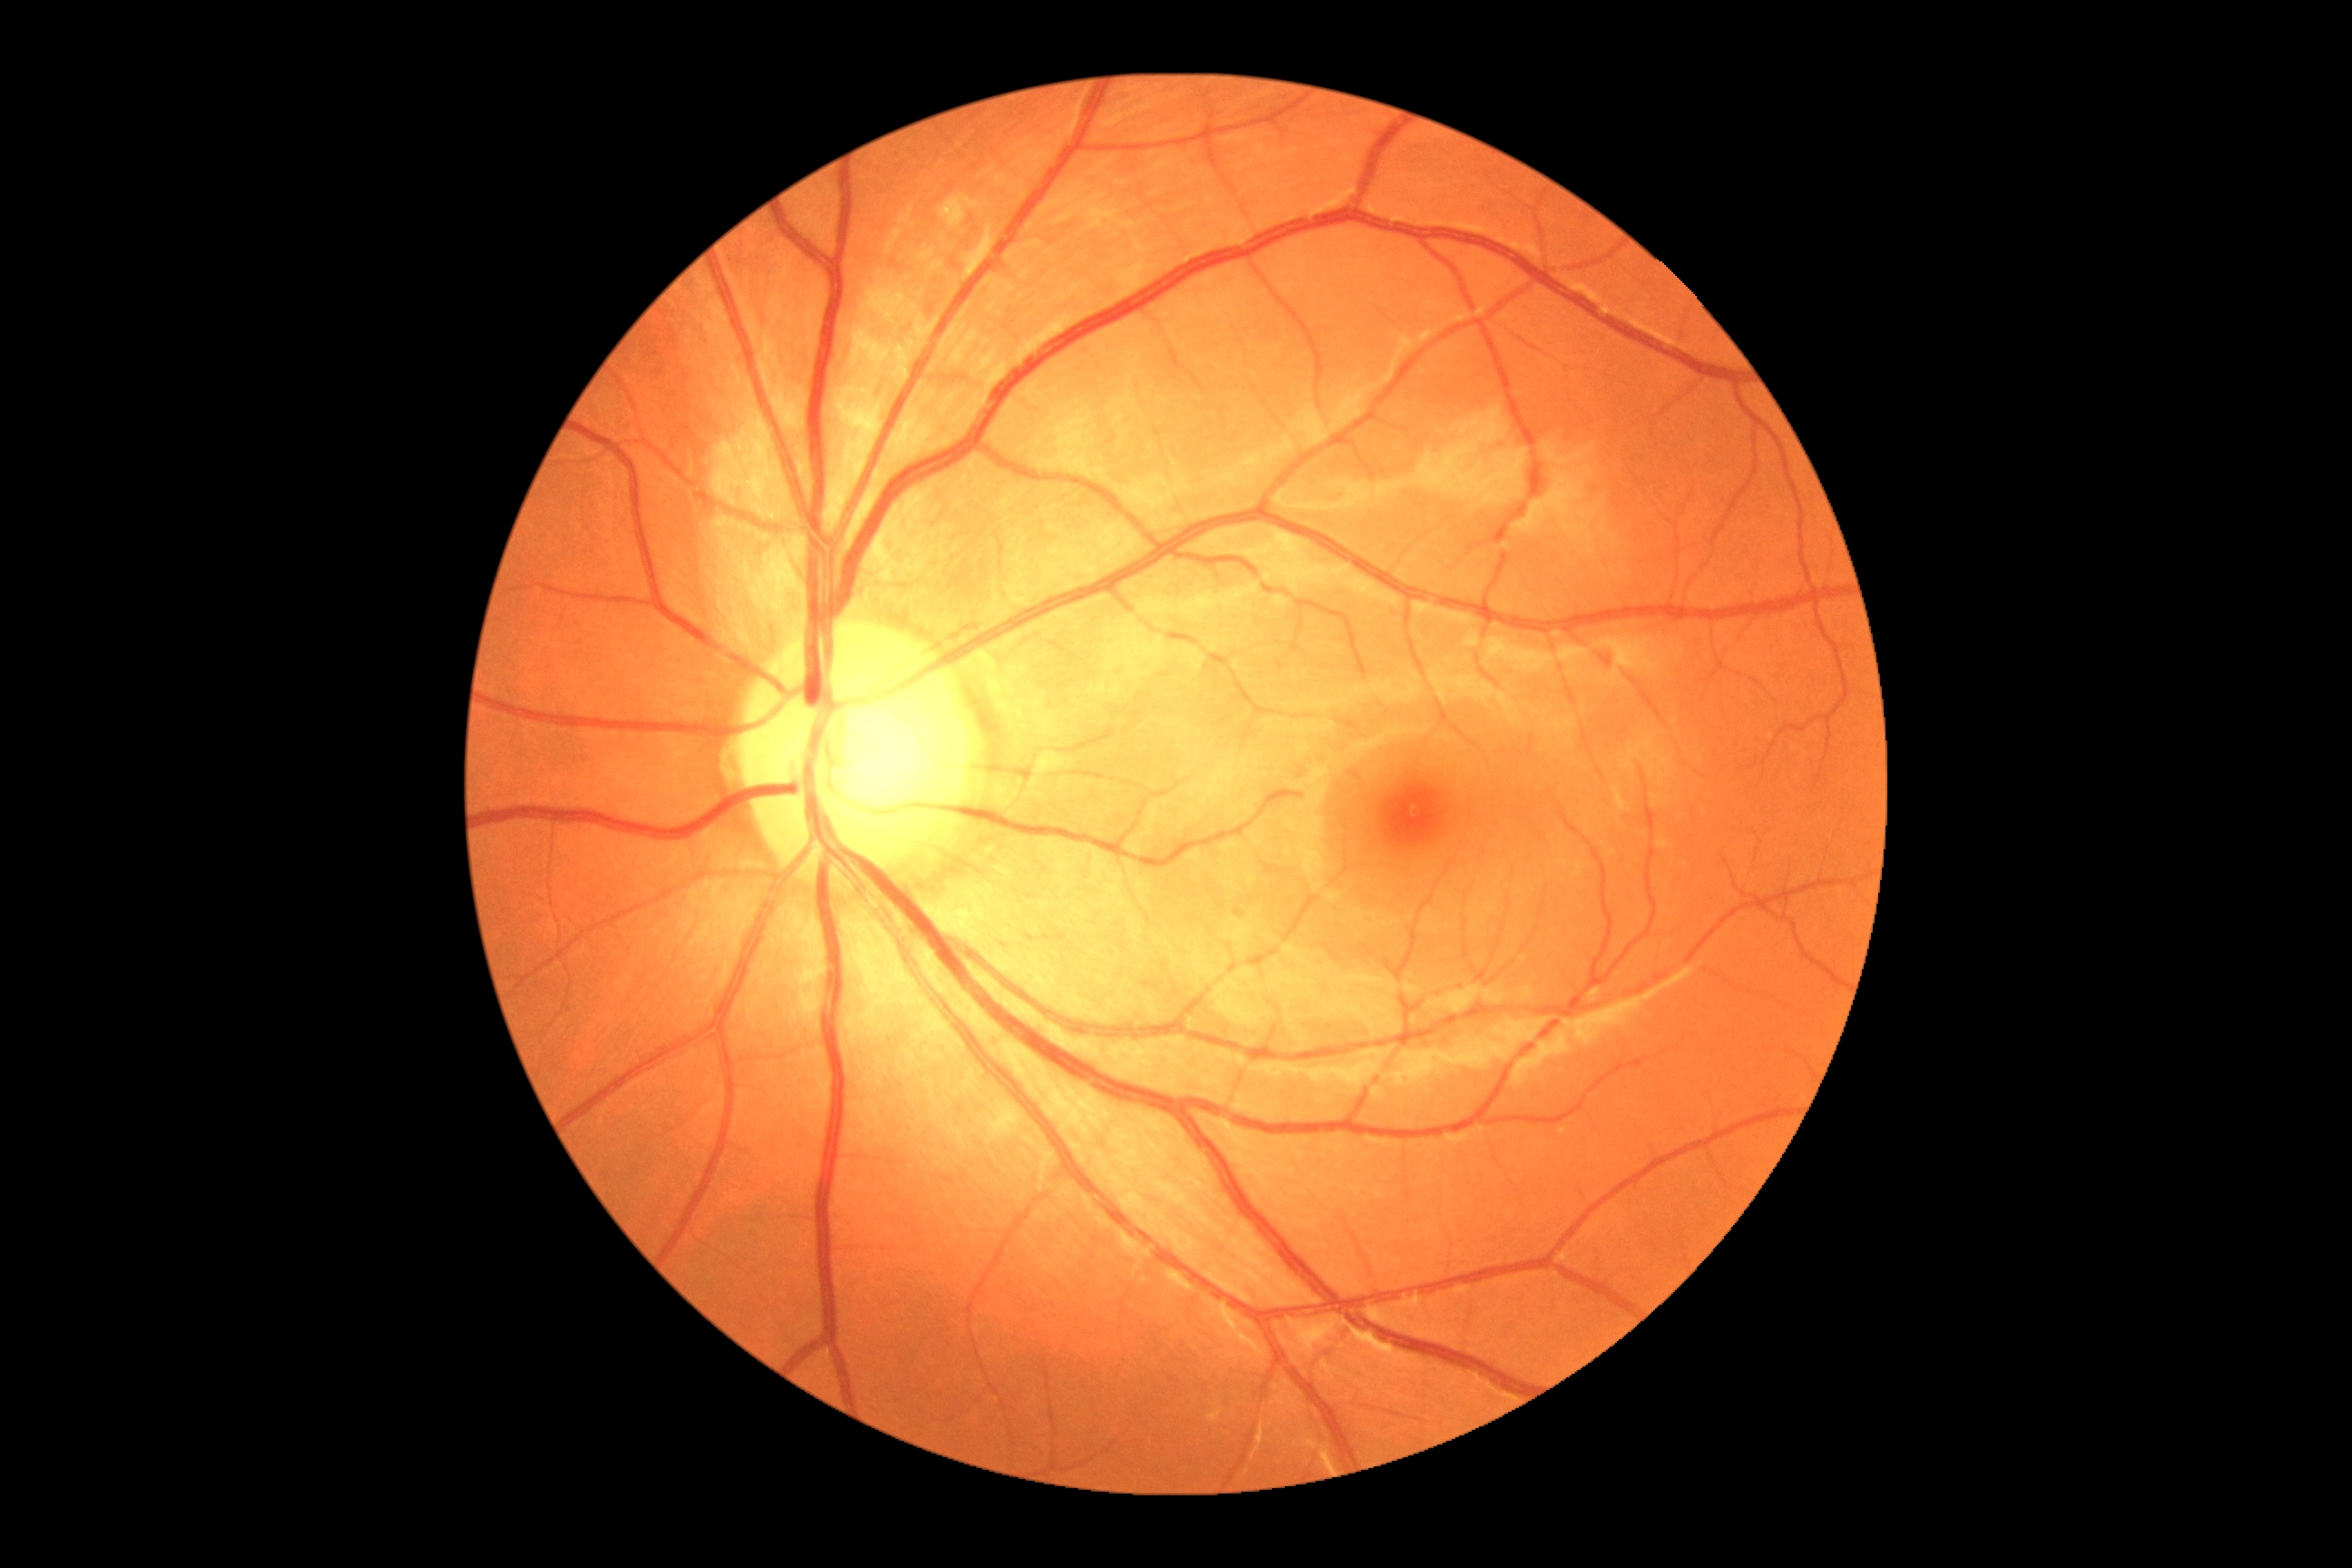
{
  "dr_grade": "0/4 — no visible signs of diabetic retinopathy"
}